Pediatric retinal photograph (wide-field); camera: Clarity RetCam 3 (130° FOV)
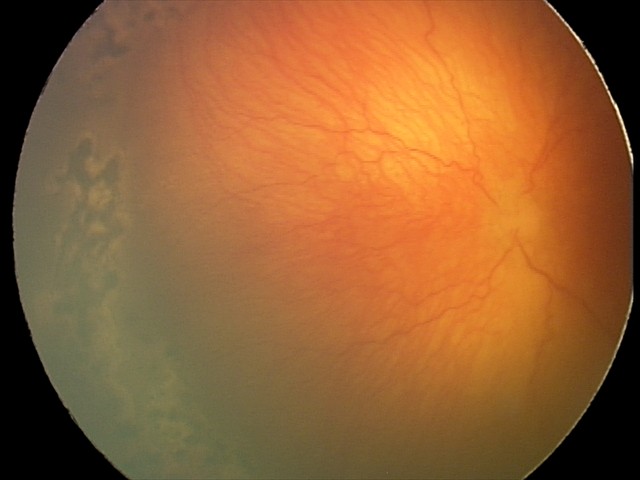 From an examination with diagnosis of aggressive ROP (A-ROP).